NIDEK AFC-230, 45° field of view, no pharmacologic dilation: 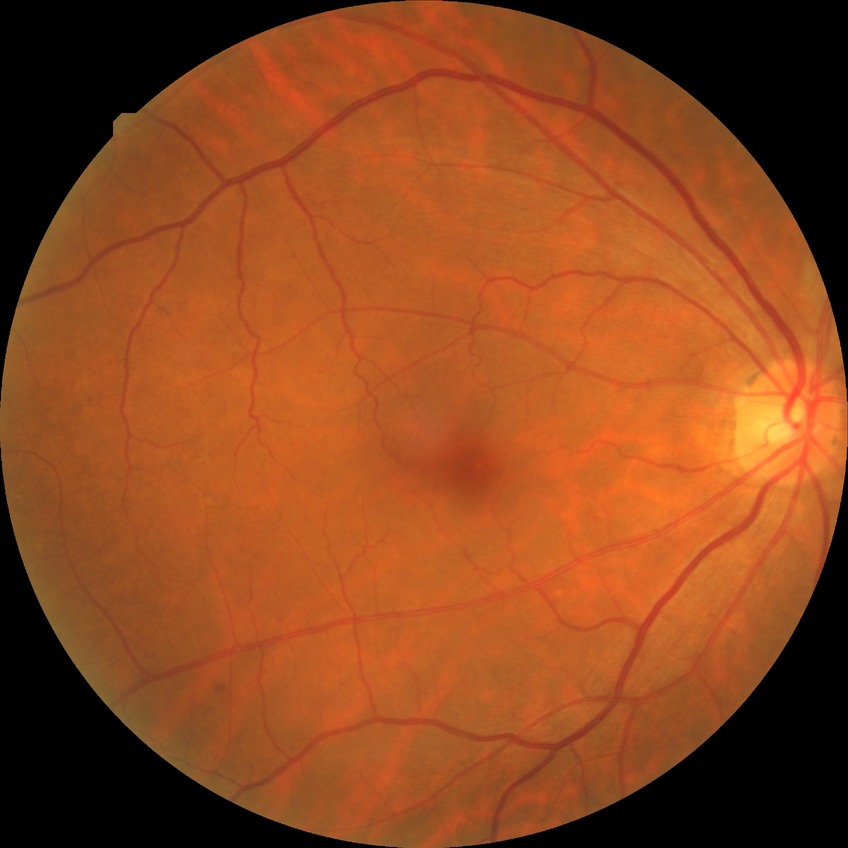

Diabetic retinopathy (DR) is simple diabetic retinopathy (SDR).